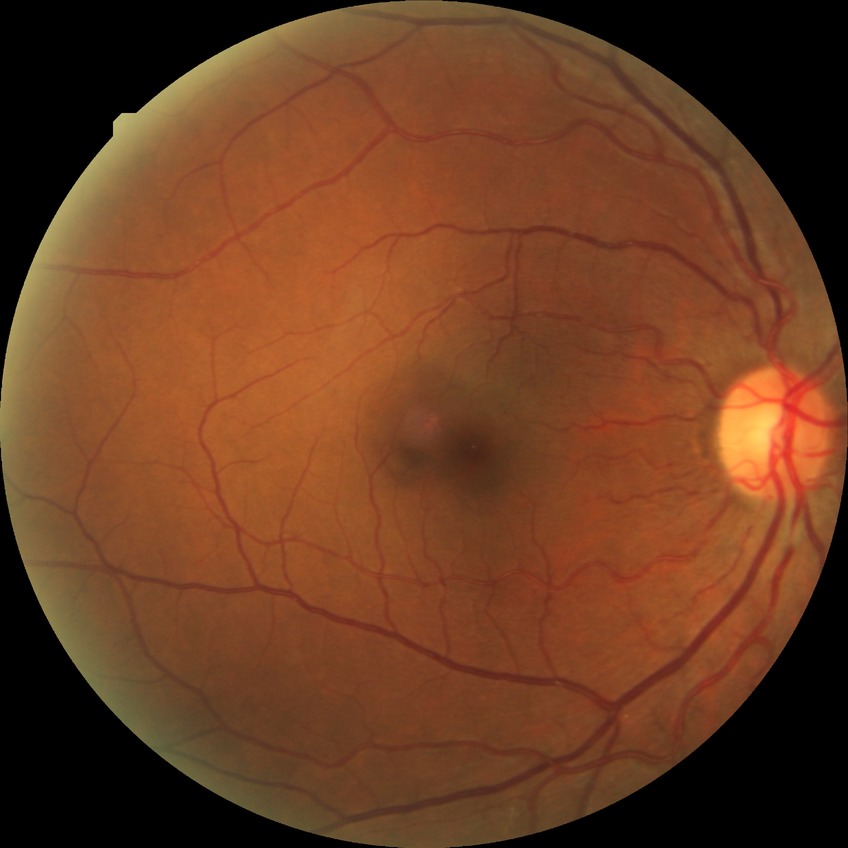
diabetic retinopathy grade = no diabetic retinopathy.